1469 by 1471 pixels
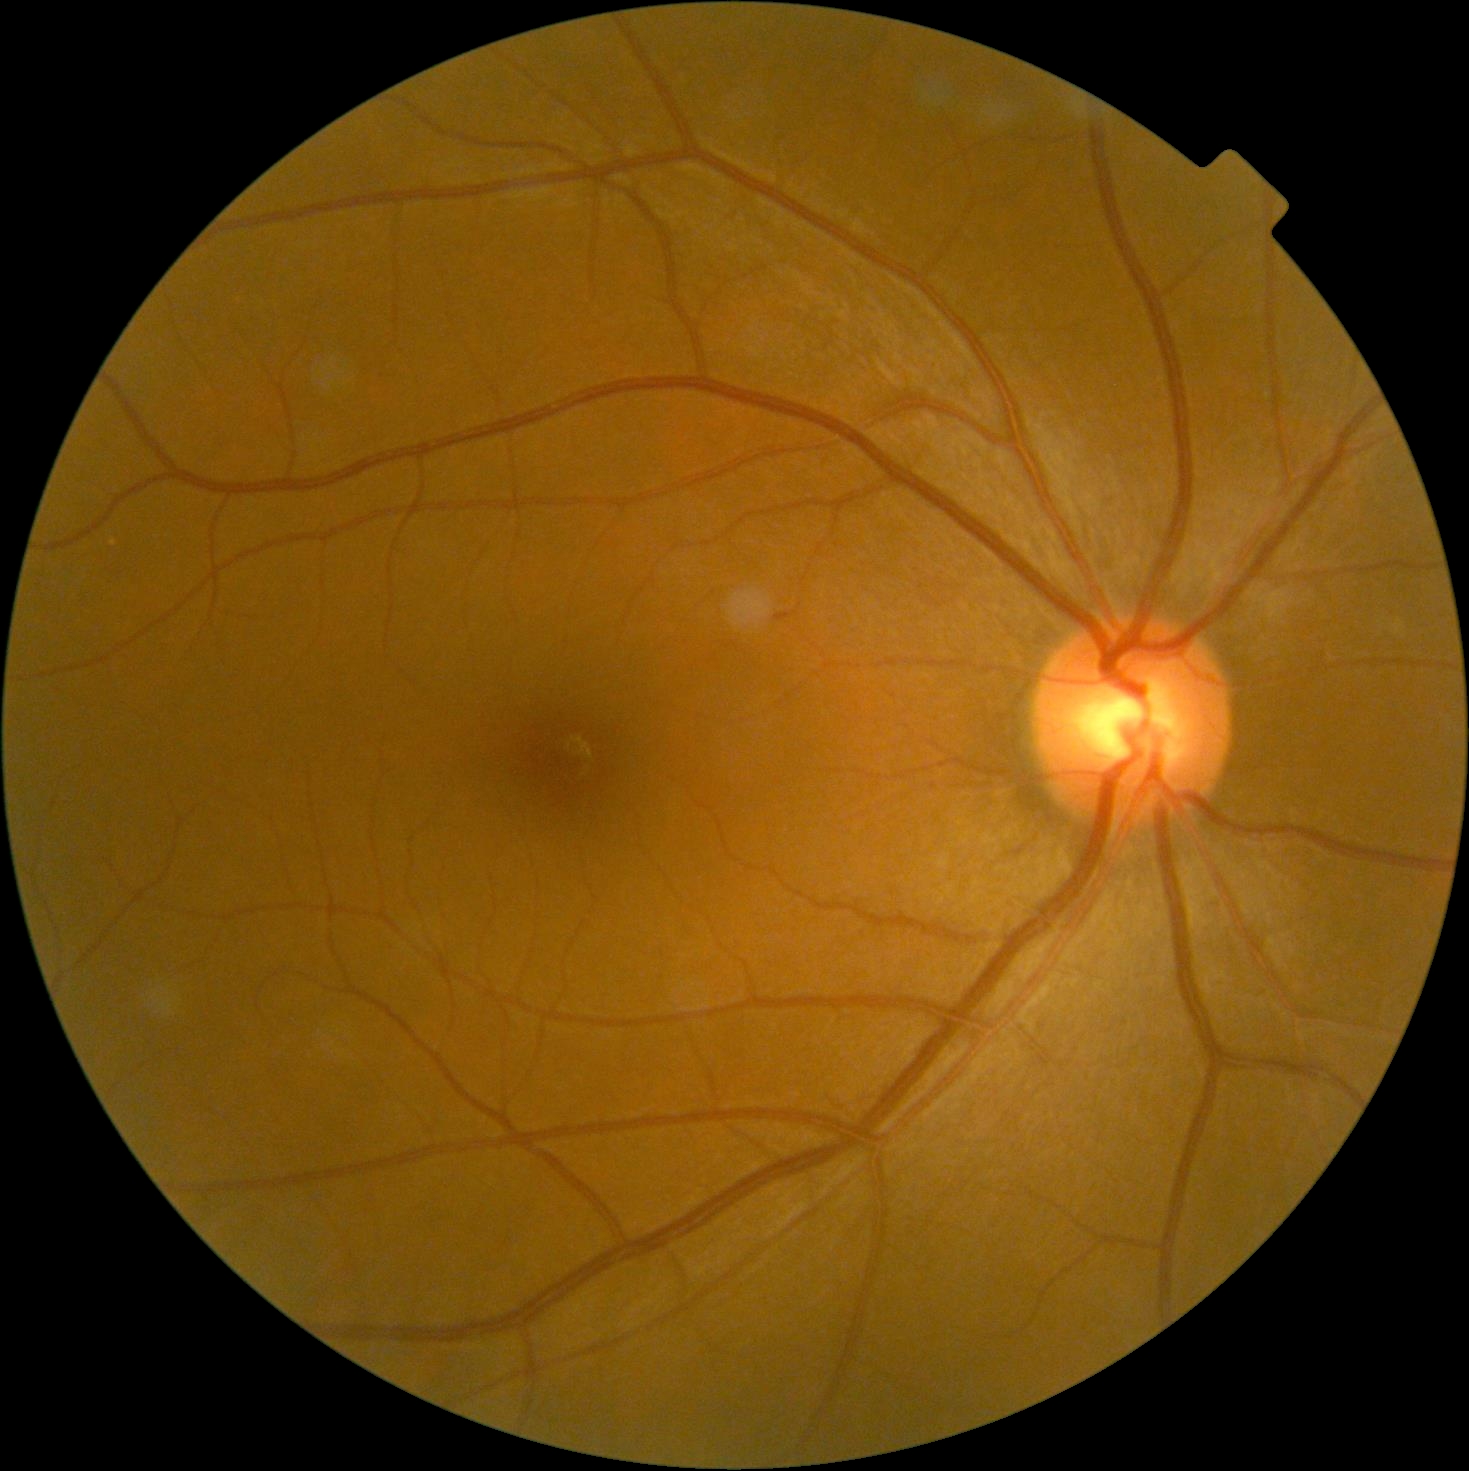

Retinopathy: grade 0 (no apparent retinopathy) — no visible signs of diabetic retinopathy.